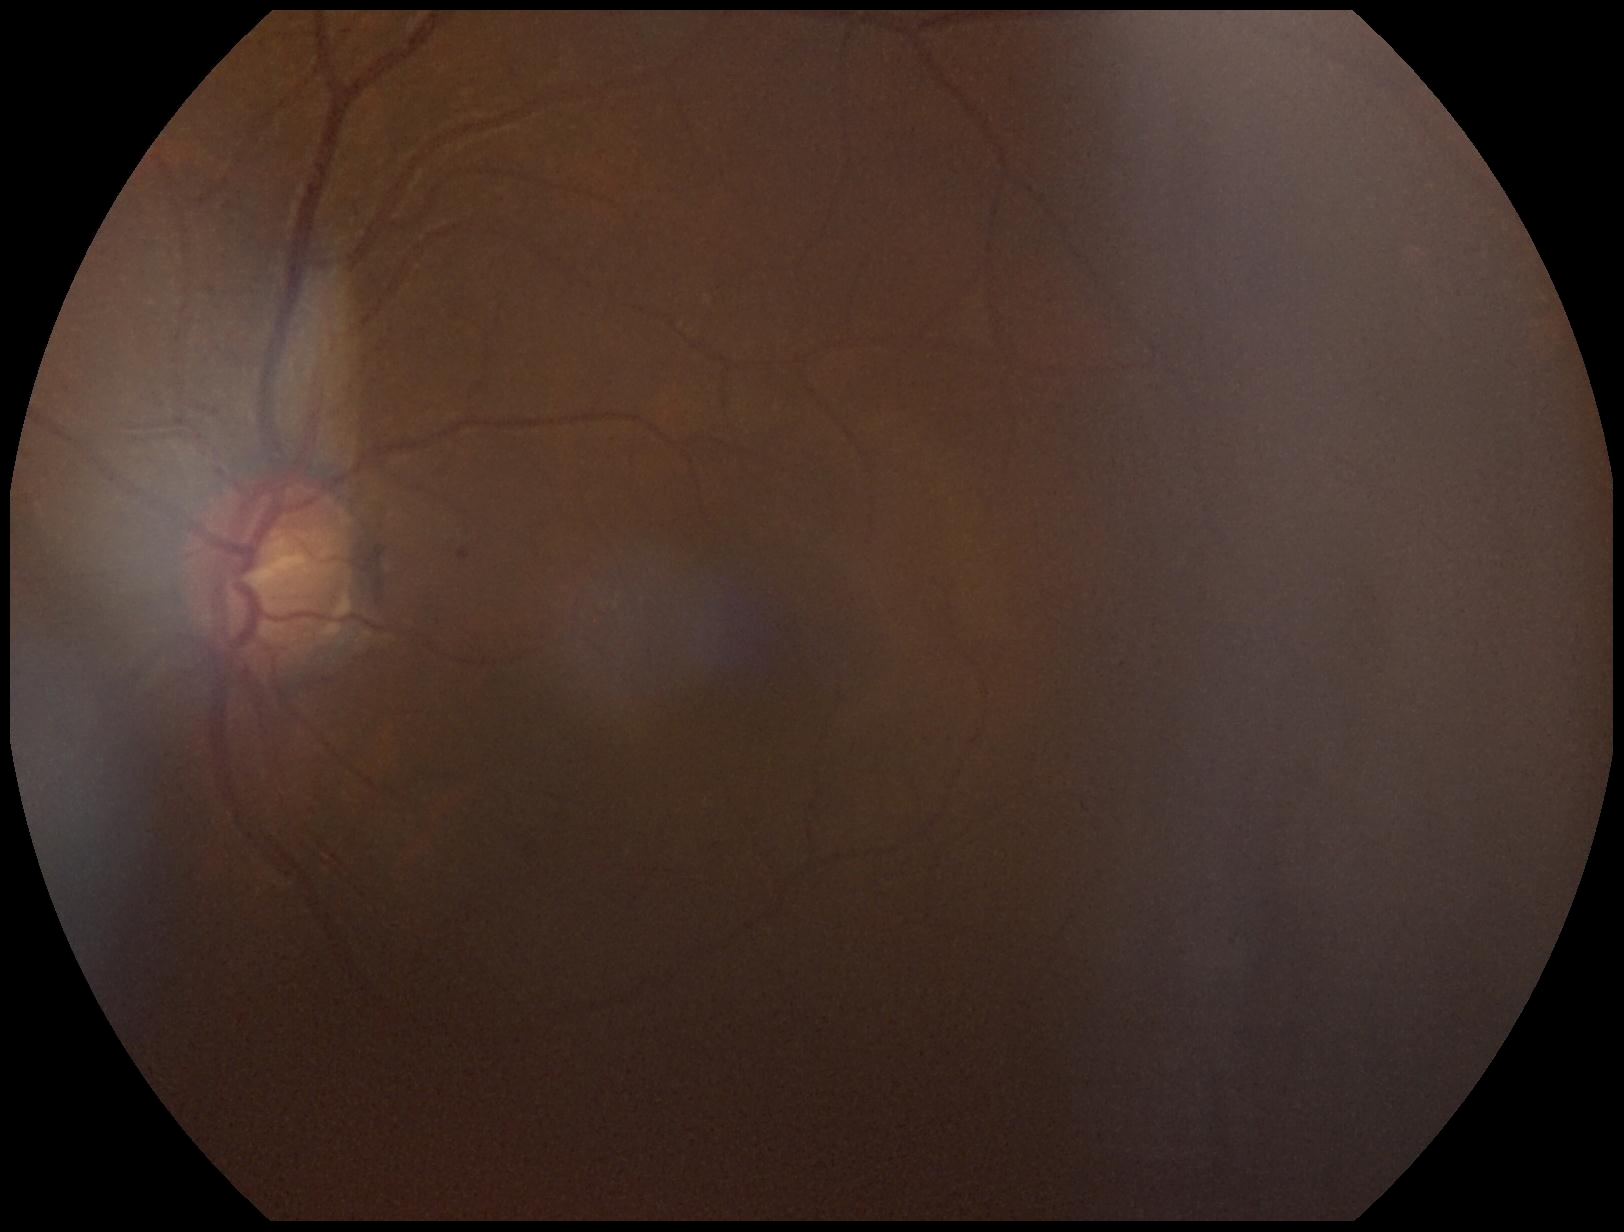
Disease class: non-proliferative diabetic retinopathy. DR: grade 1 (mild NPDR) — presence of microaneurysms only.